2212 x 1659 pixels: 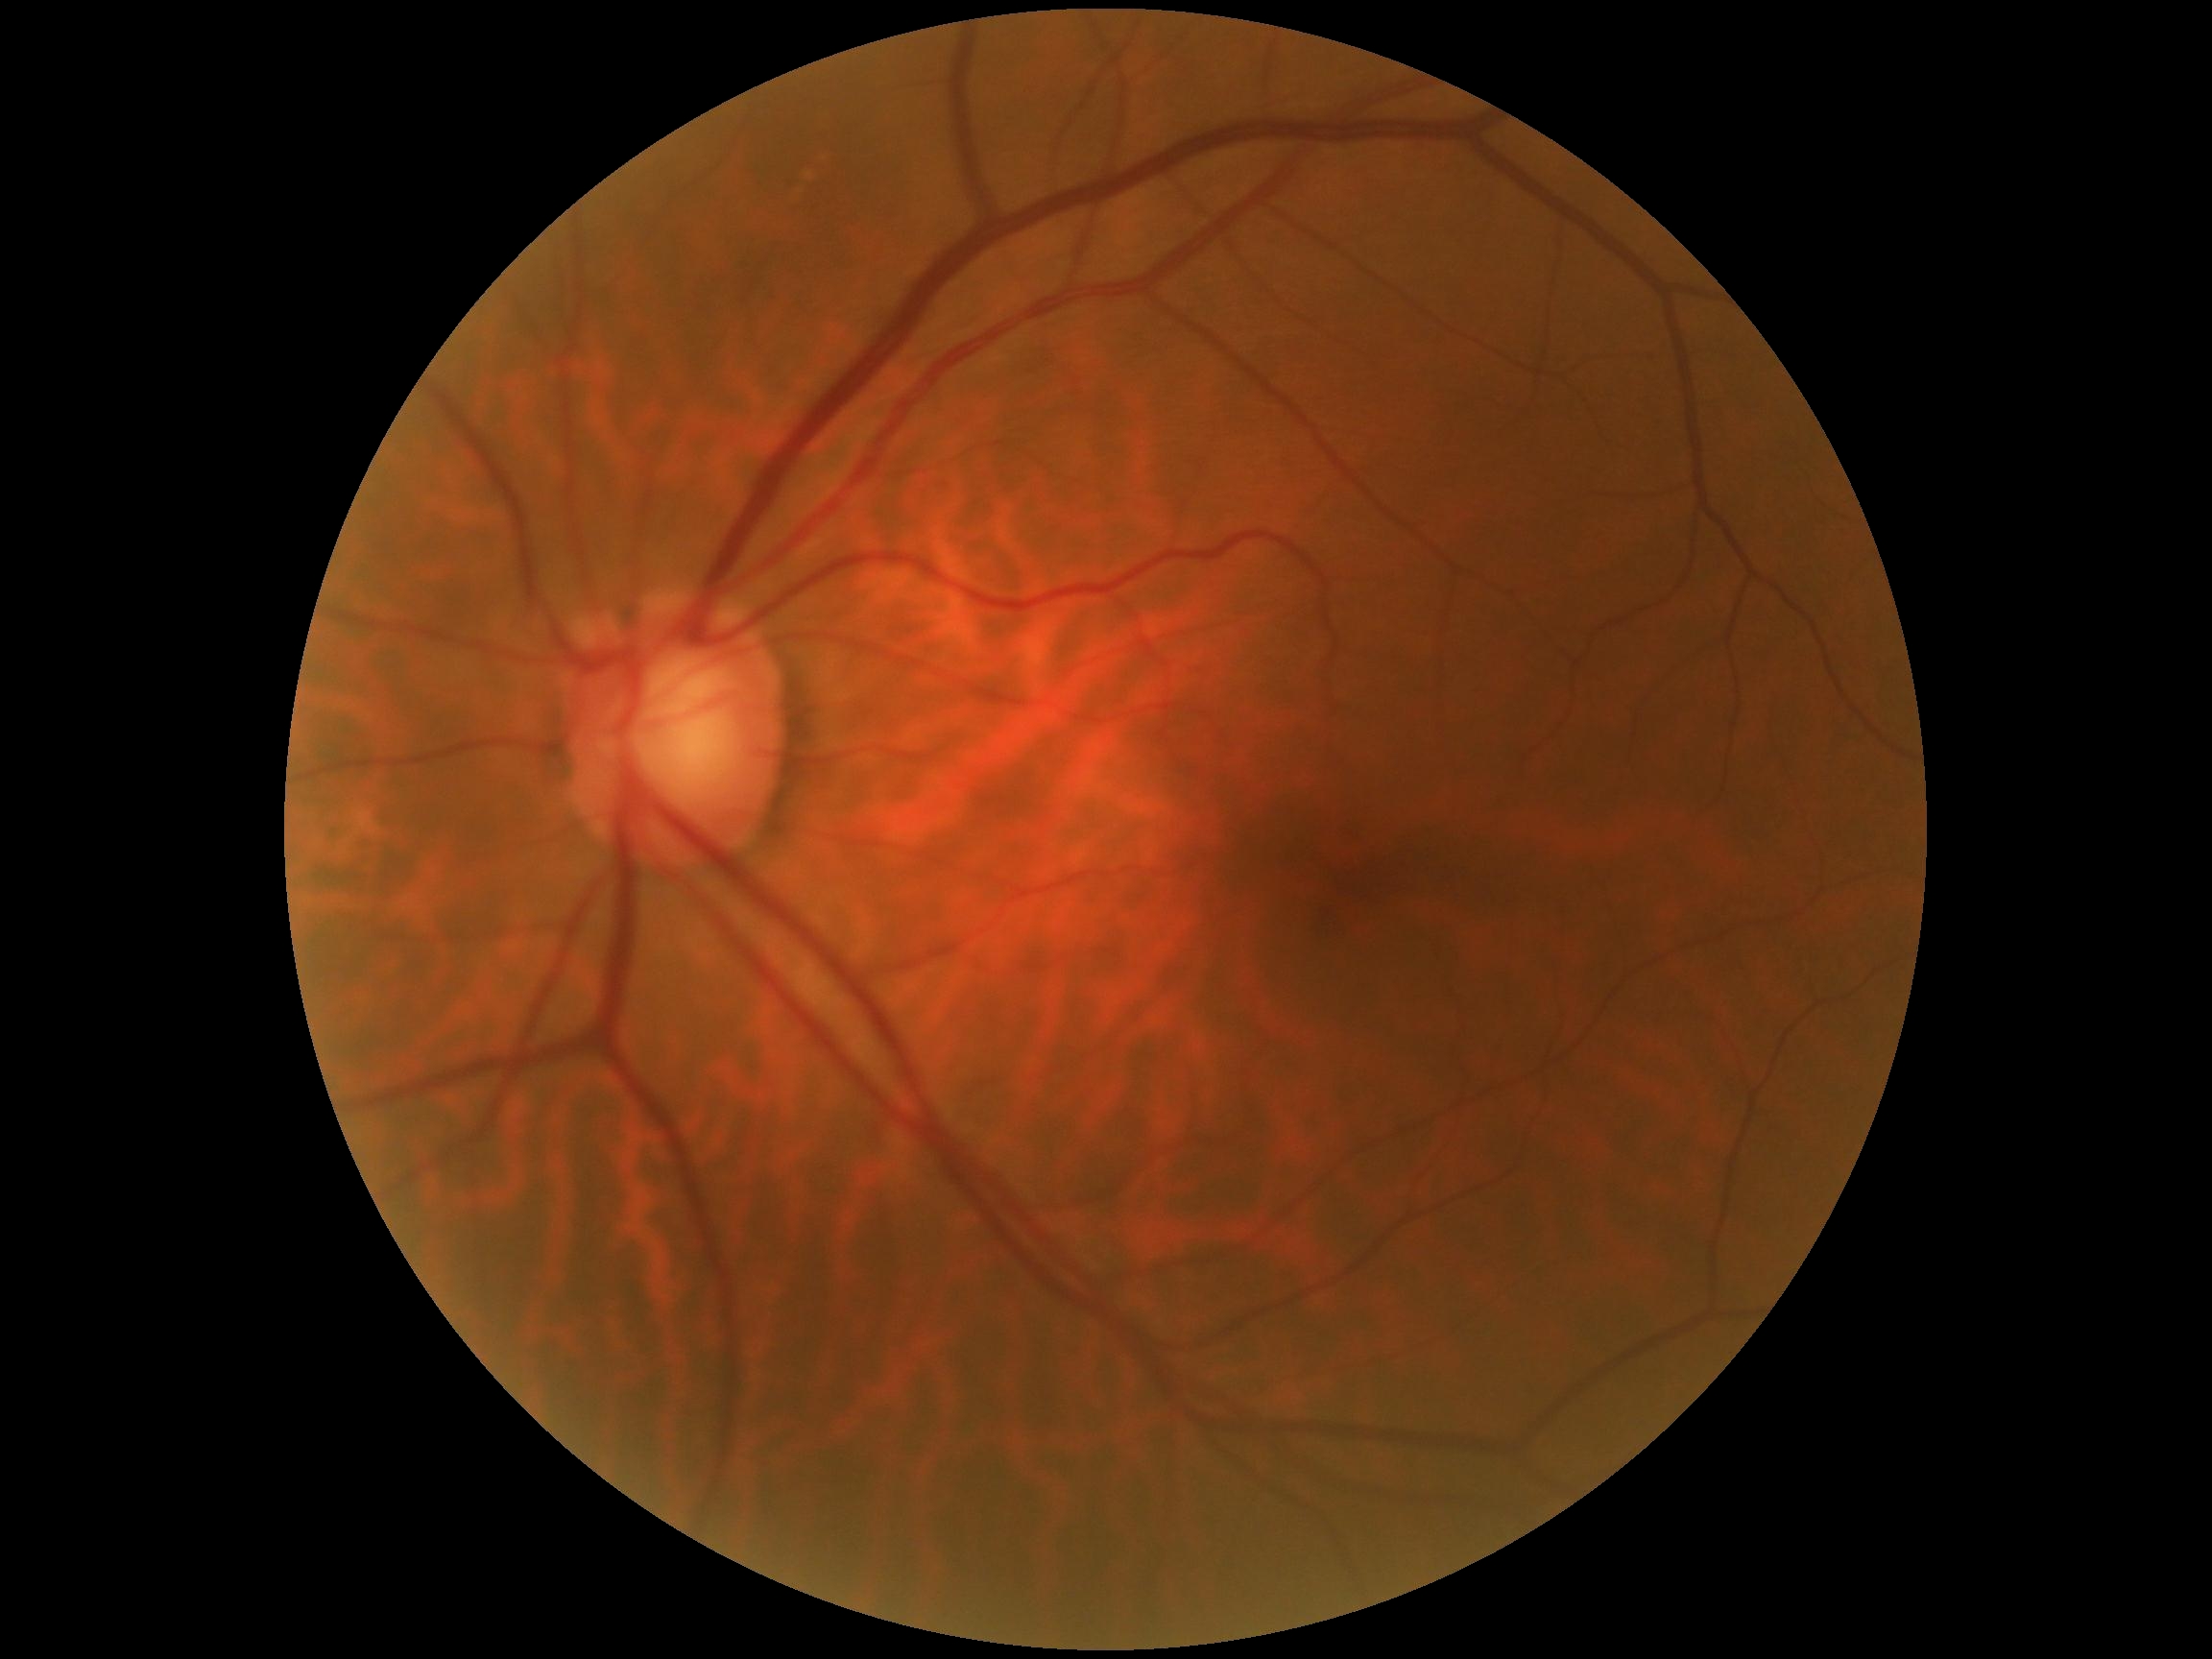
DR grade: no apparent diabetic retinopathy (0) — no visible signs of diabetic retinopathy.